Posterior pole color fundus photograph. DR severity per modified Davis staging — 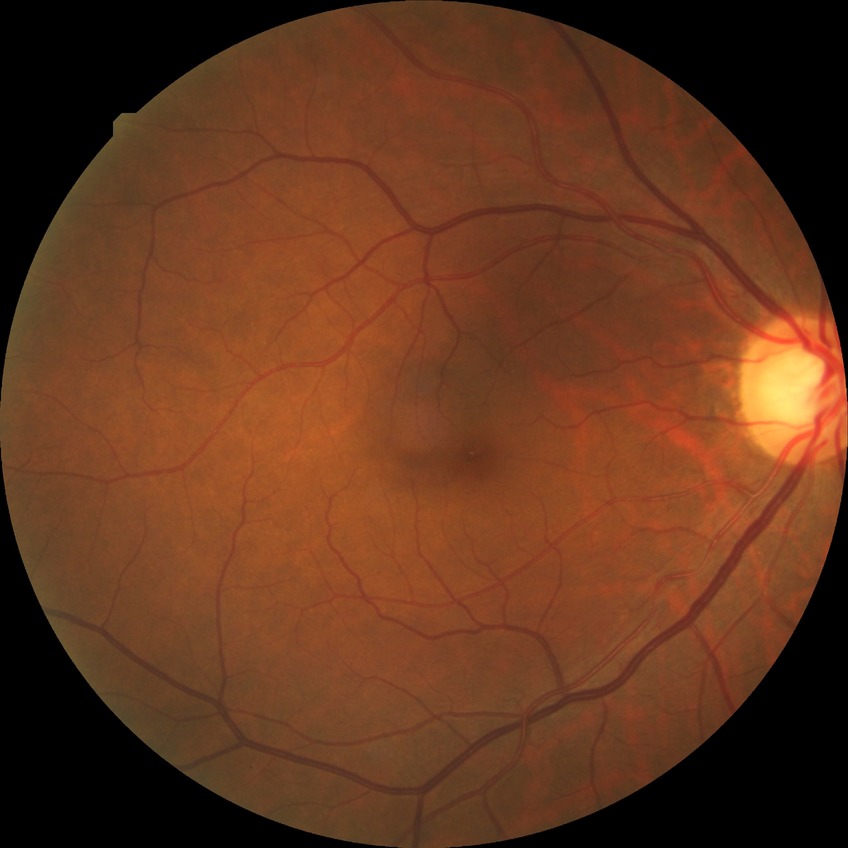
Davis DR grade: NDR.